45° FOV, color fundus image — 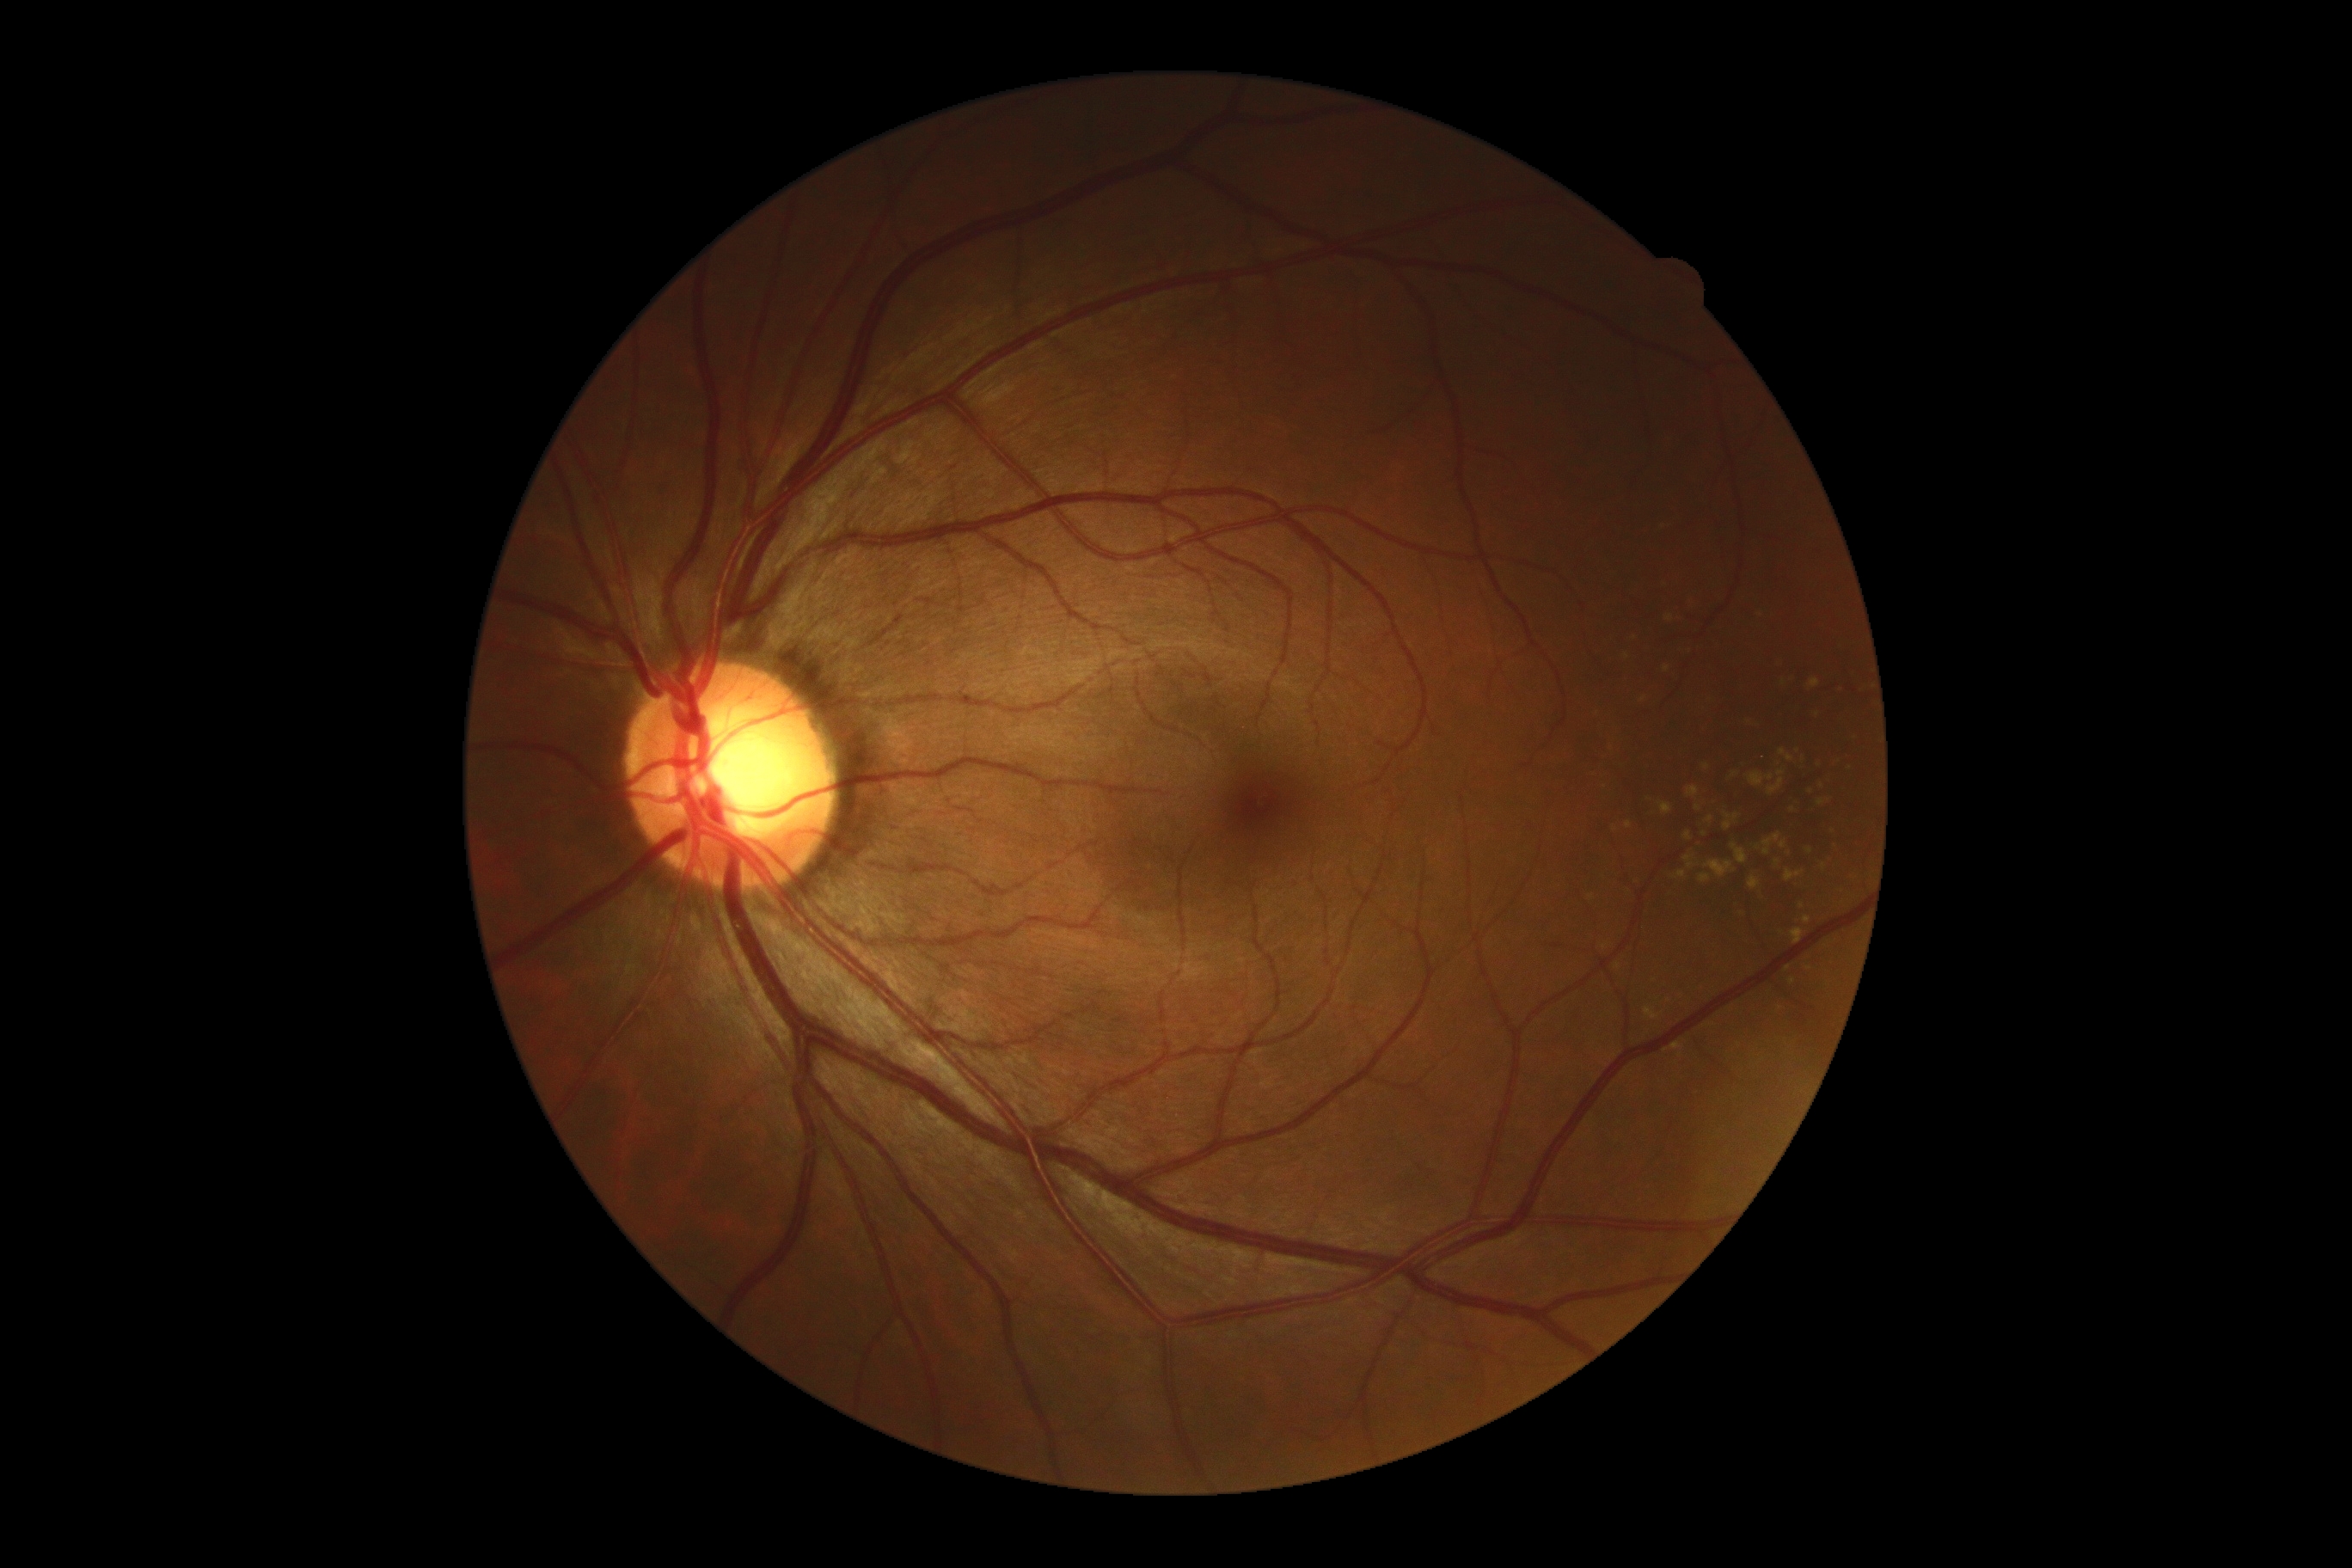

Findings:
– retinopathy grade — no apparent retinopathy (0)